1924x1556:
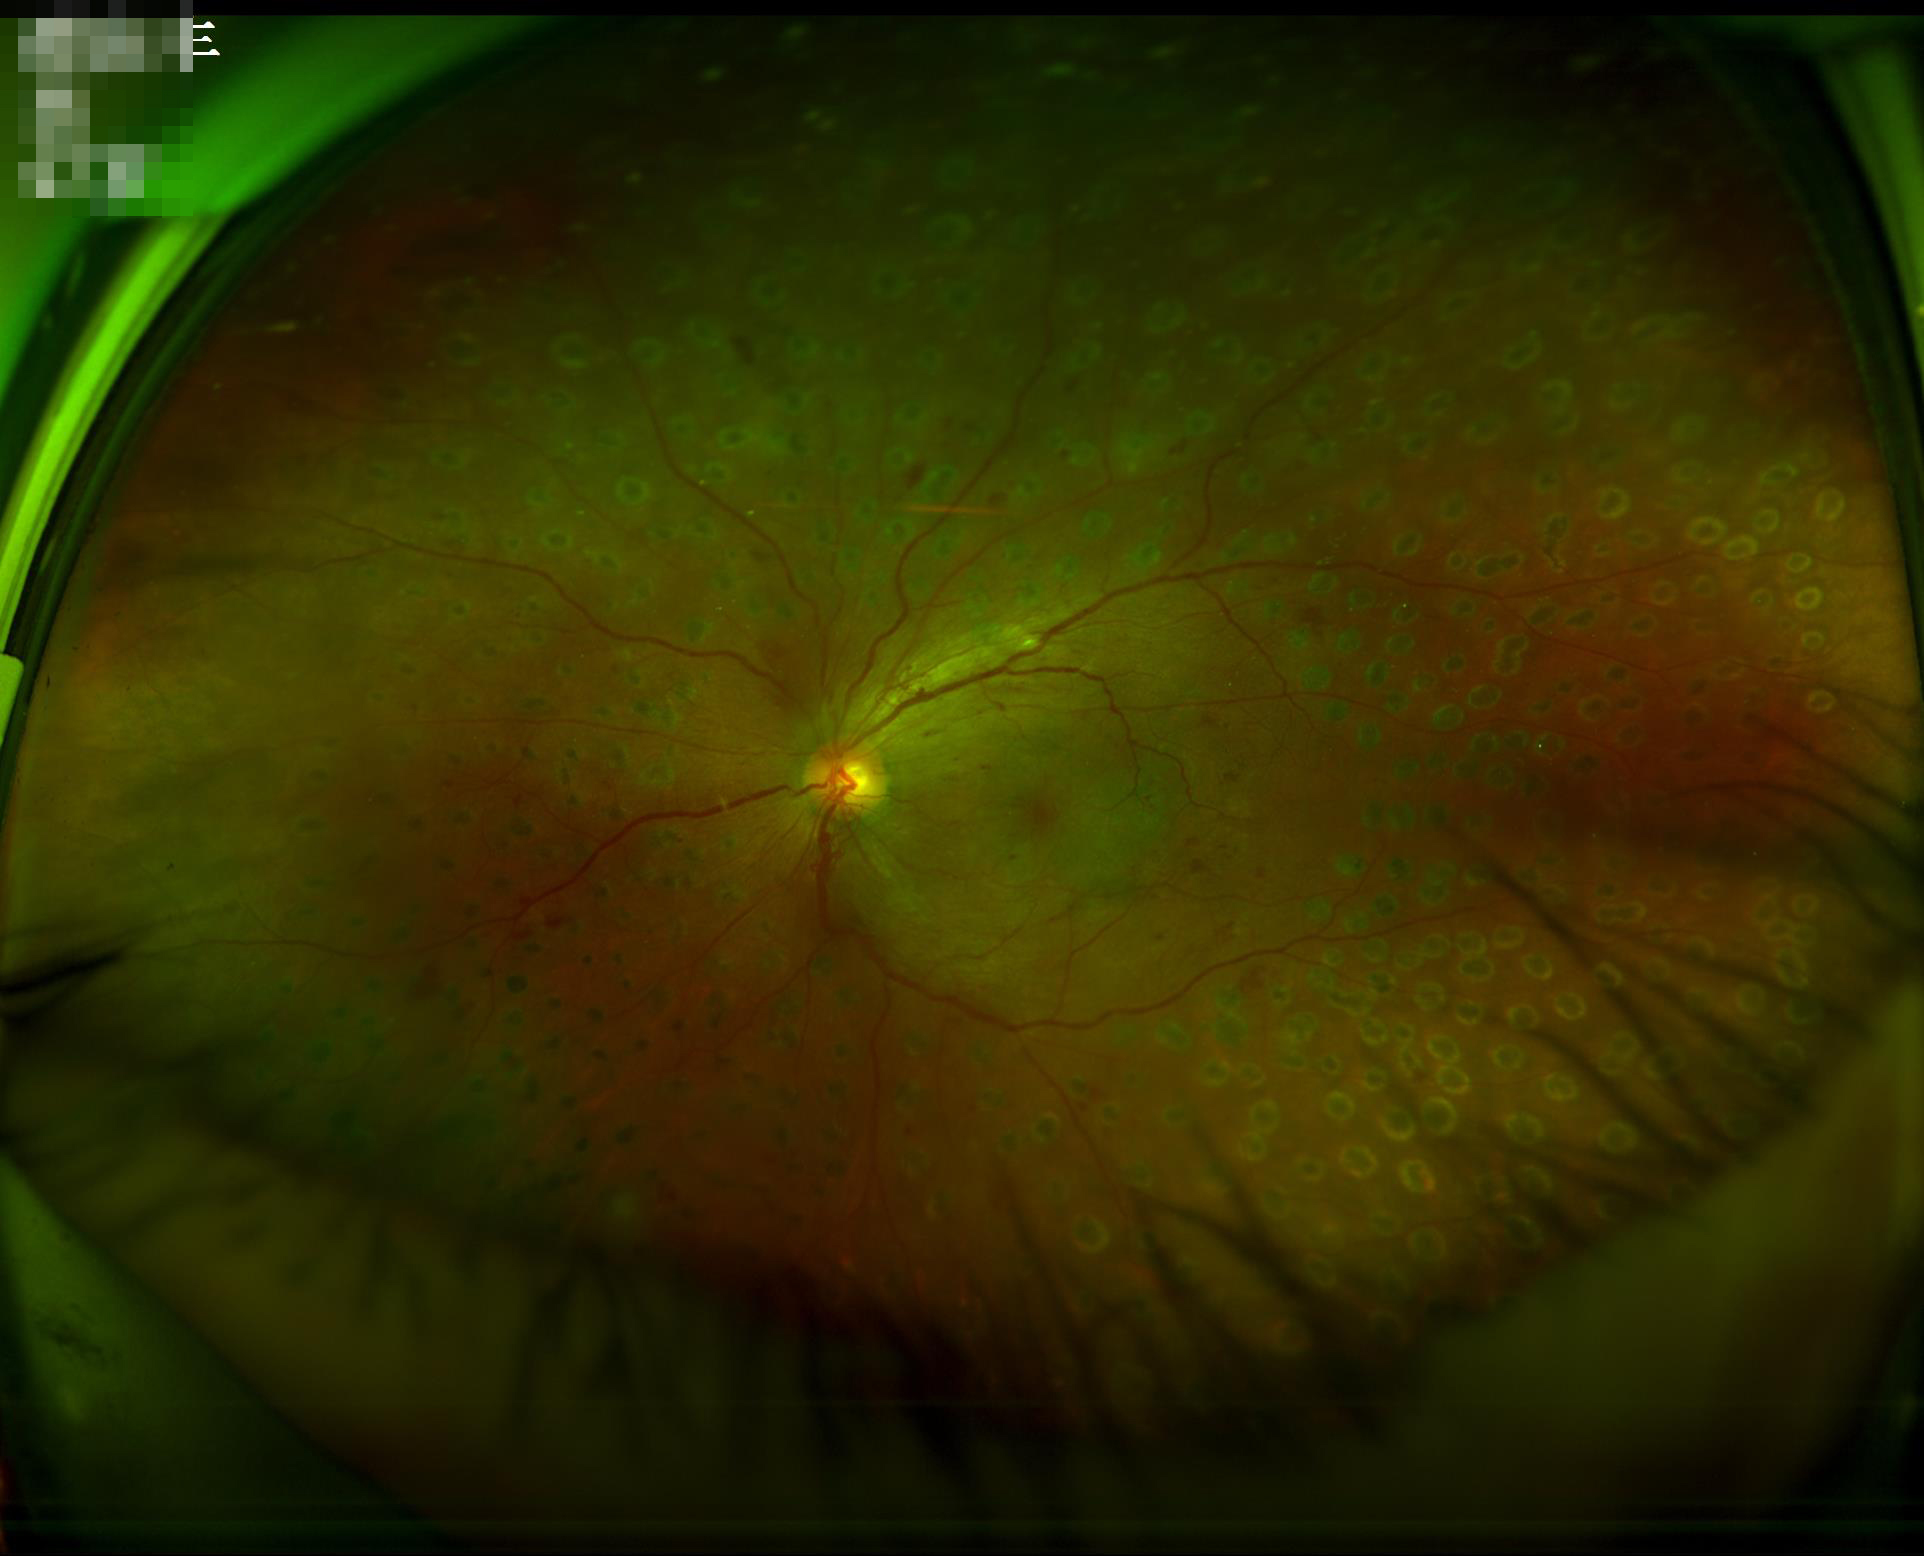

Overall quality: satisfactory; Contrast: adequate.